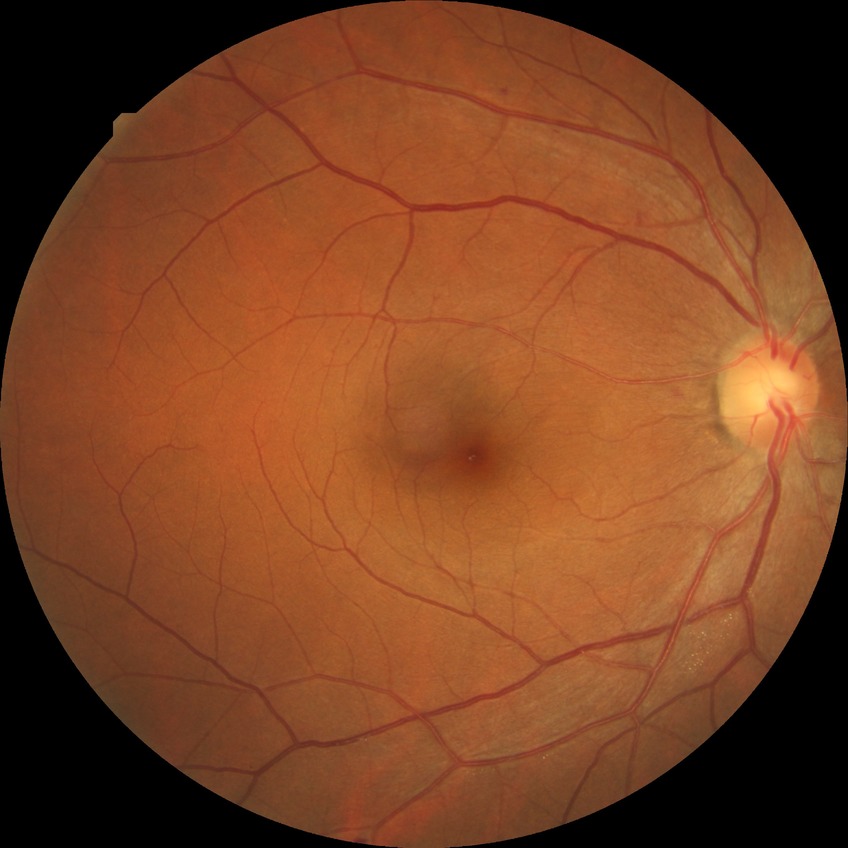

{
  "davis_grade": "SDR"
}